Retinal fundus photograph. 50° field of view.
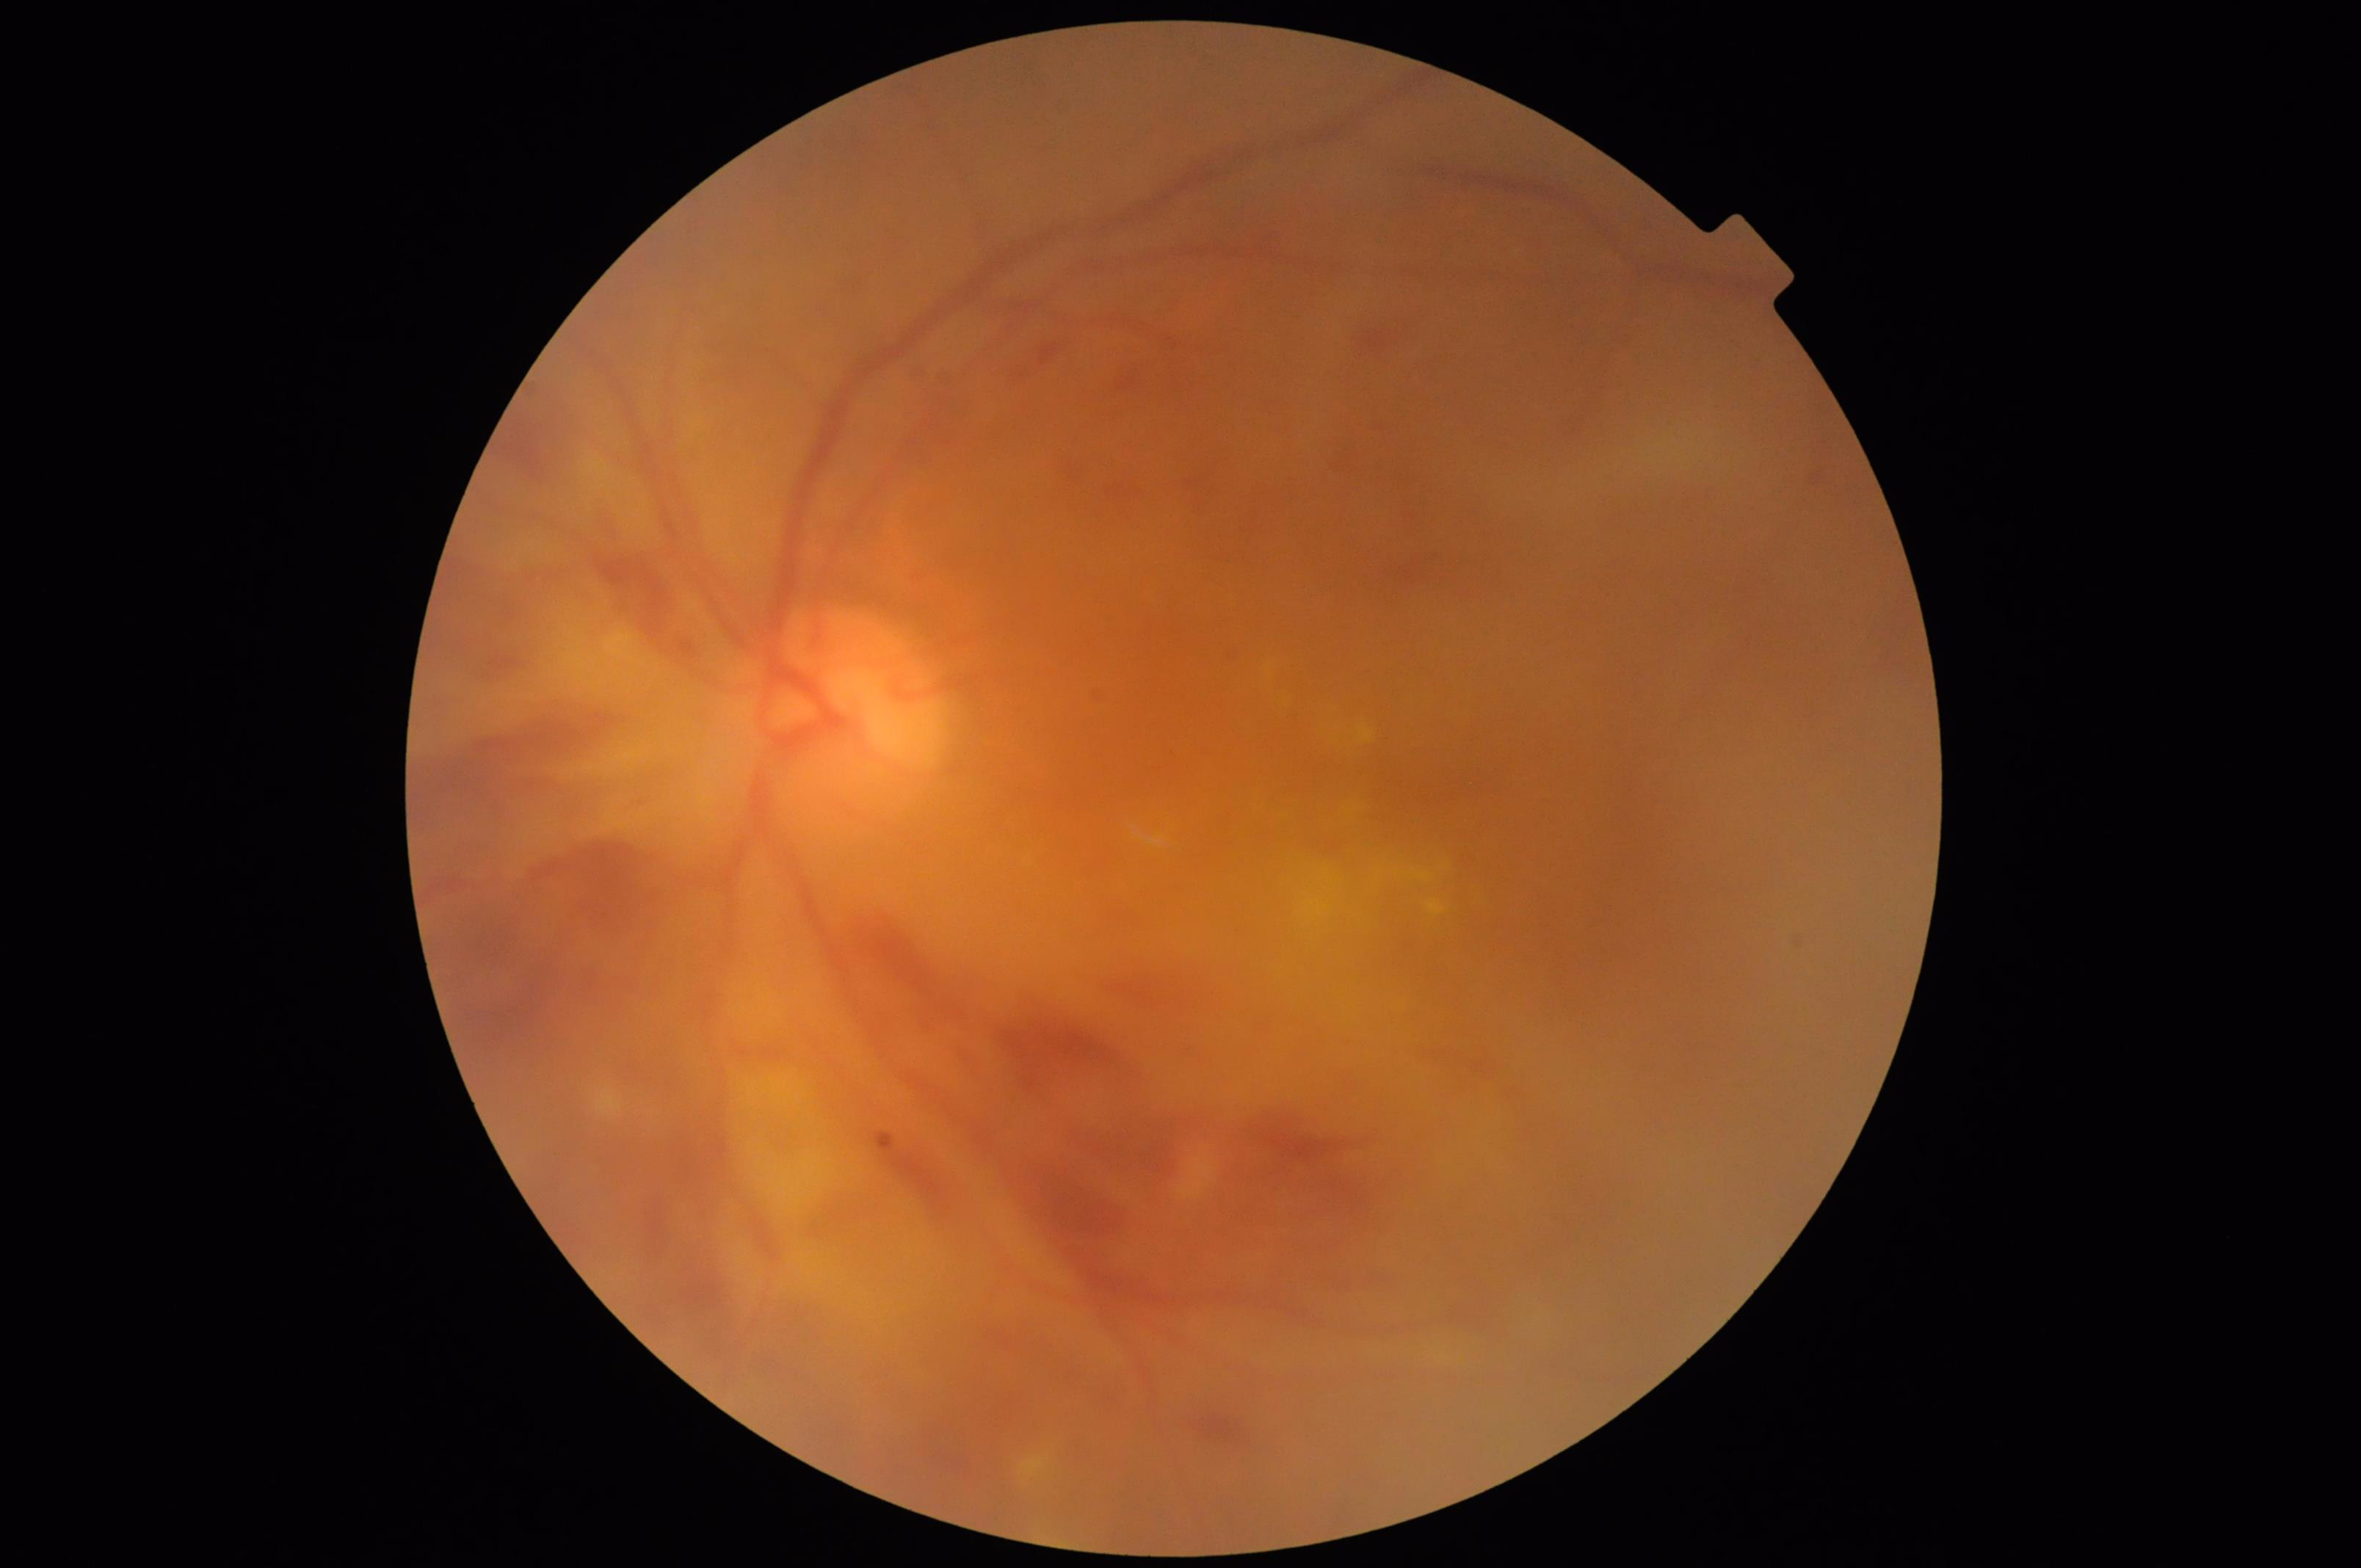
Focus: out of focus, structures indistinct
Contrast: poor dynamic range
Illumination/color: no over- or under-exposure
Overall: poor, ungradable